Diabetic retinopathy graded by the modified Davis classification · nonmydriatic — 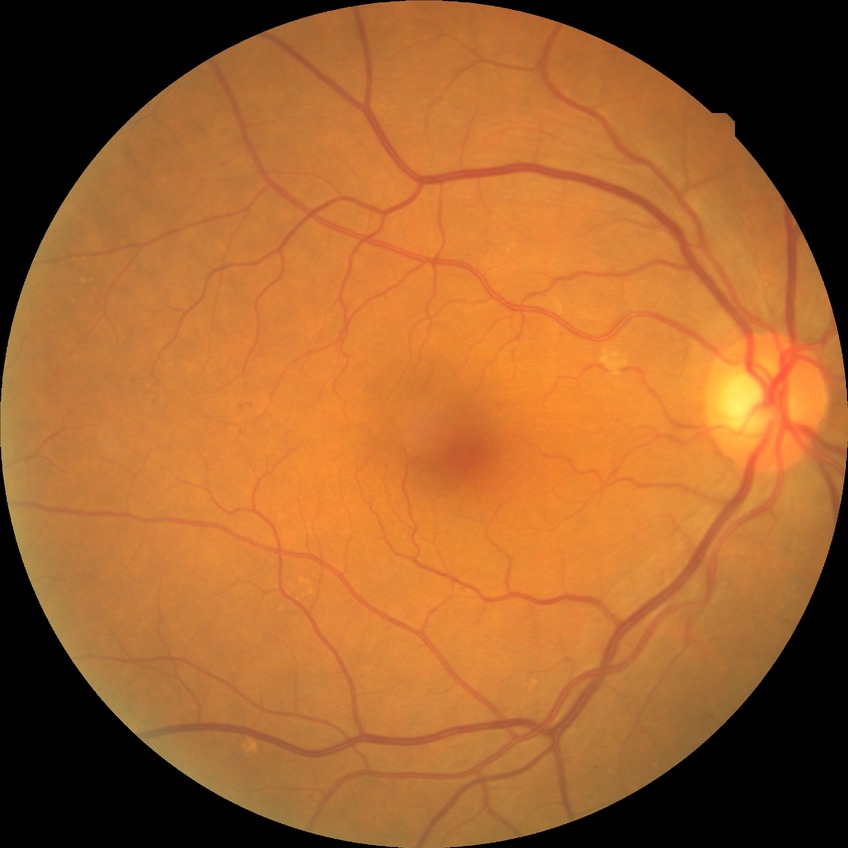 DR stage: NDR.